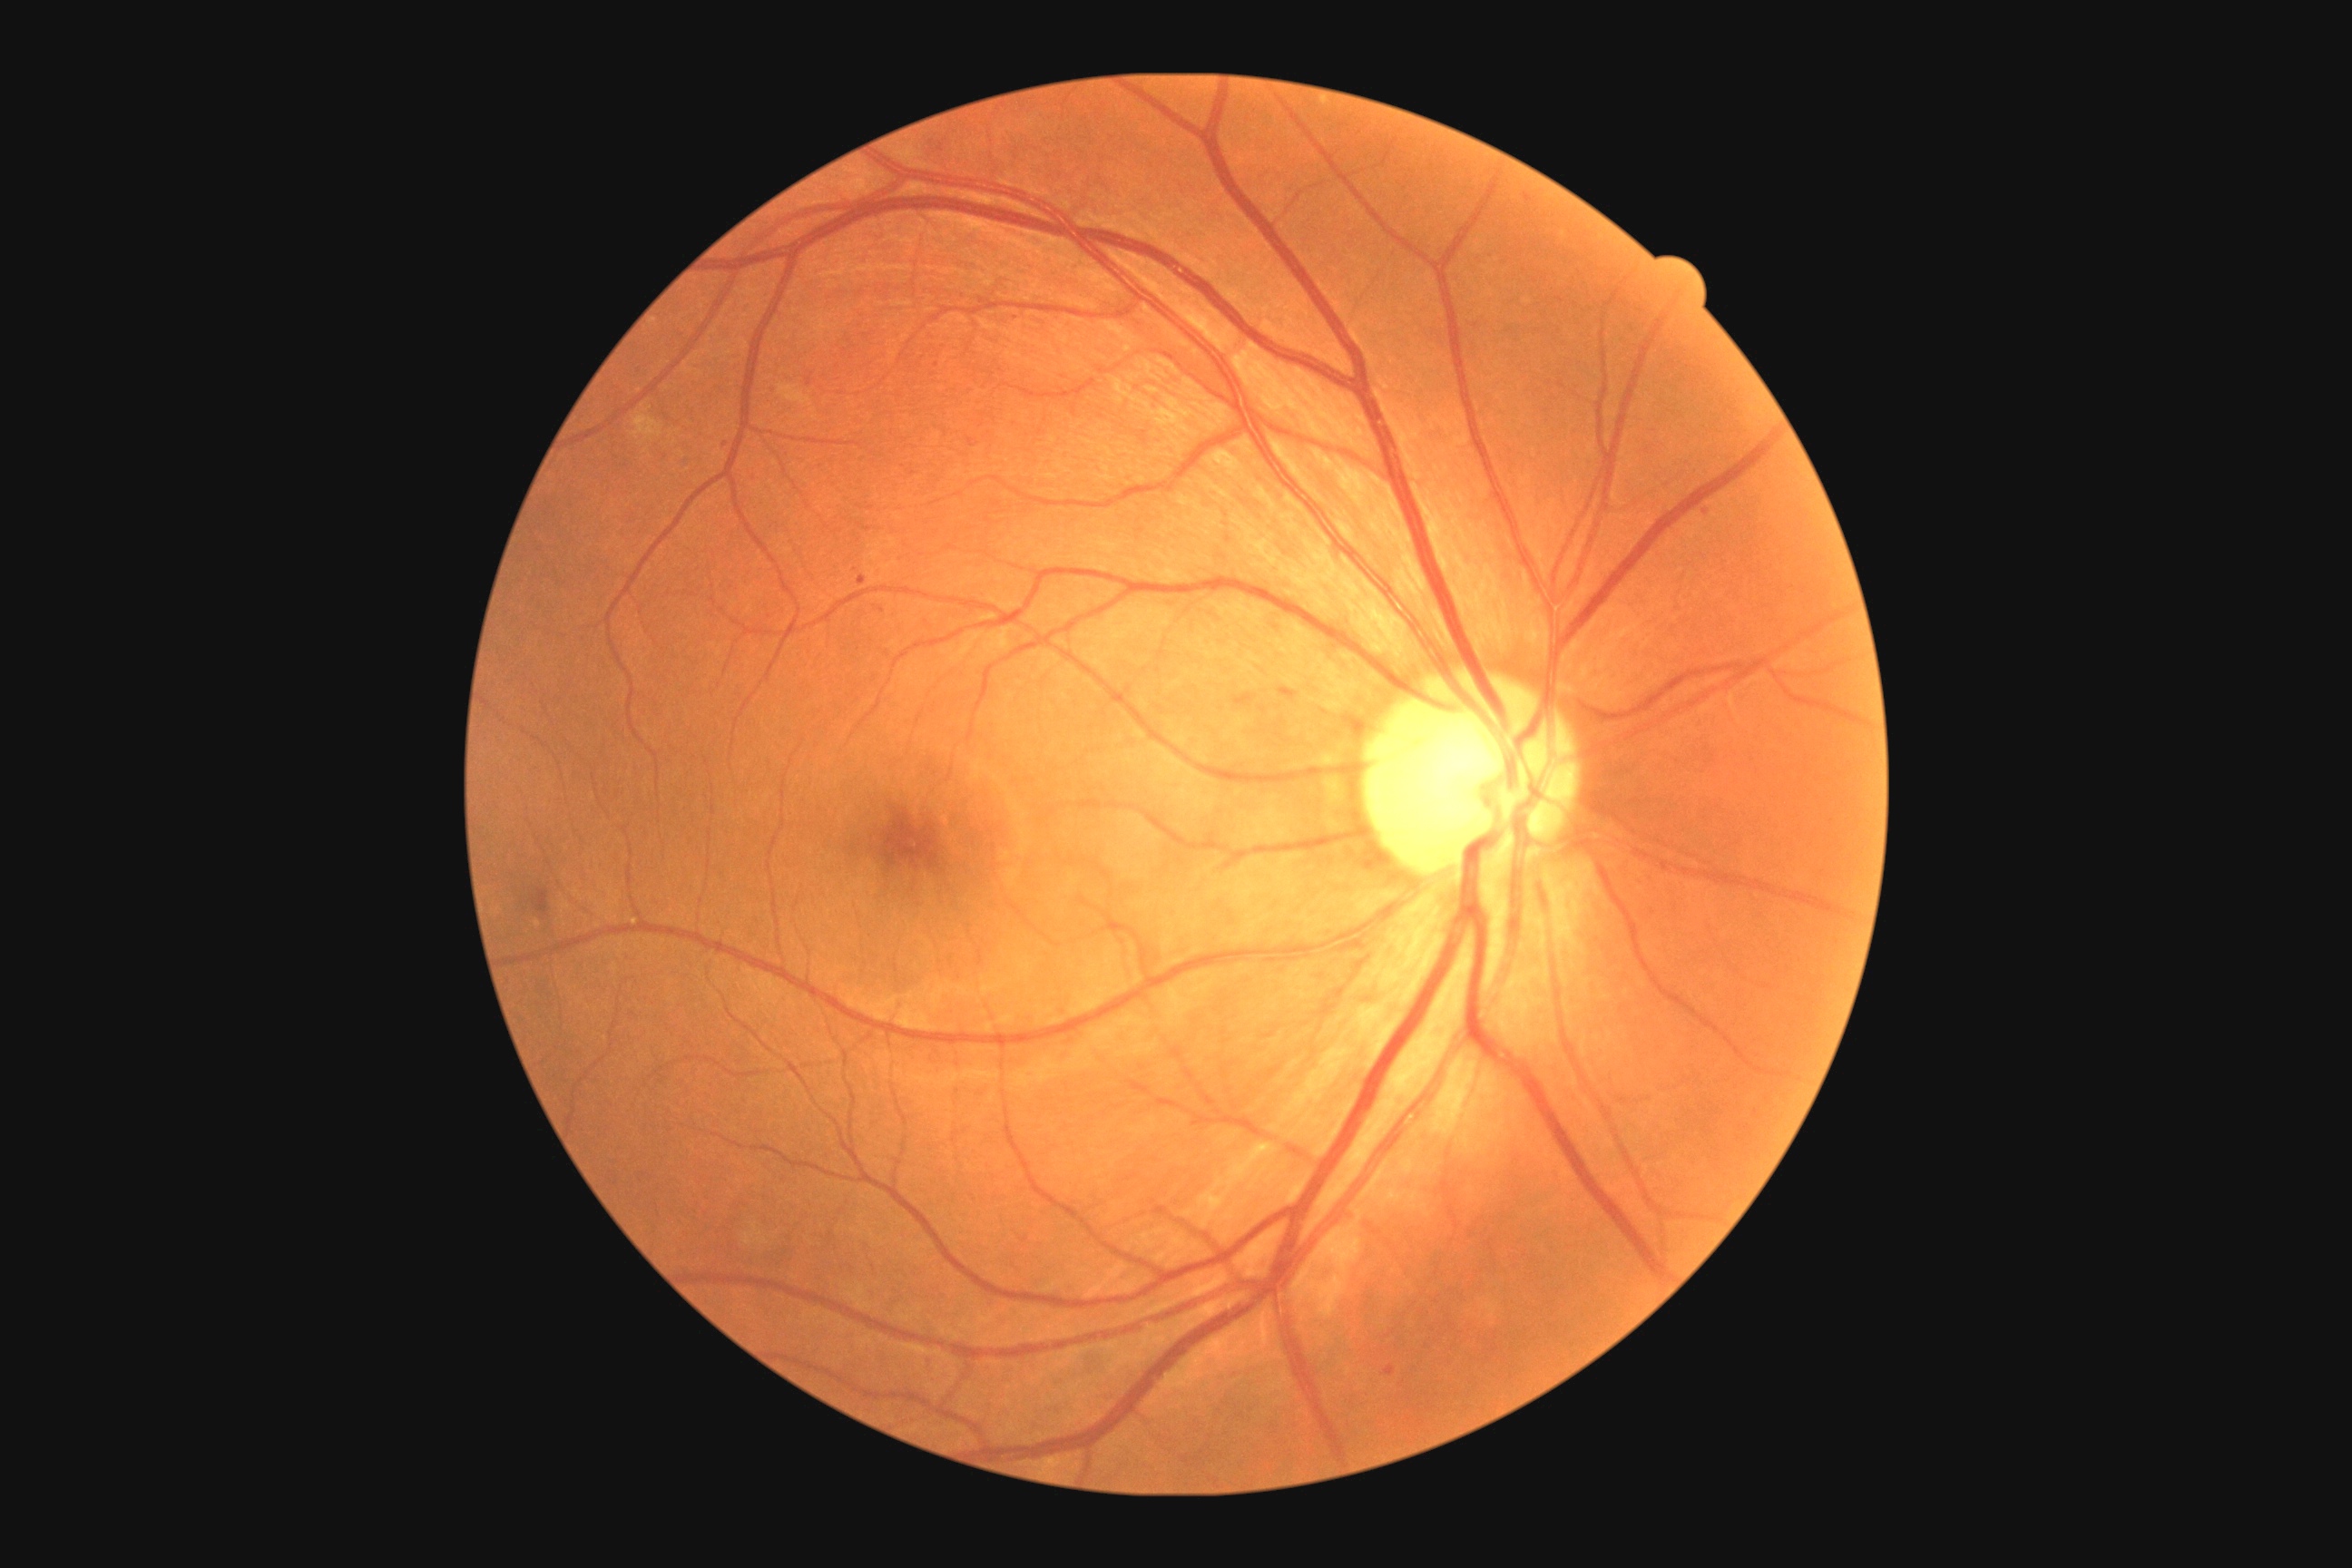
DR severity: moderate non-proliferative diabetic retinopathy (grade 2)